NIDEK AFC-230 fundus camera · DR severity per modified Davis staging
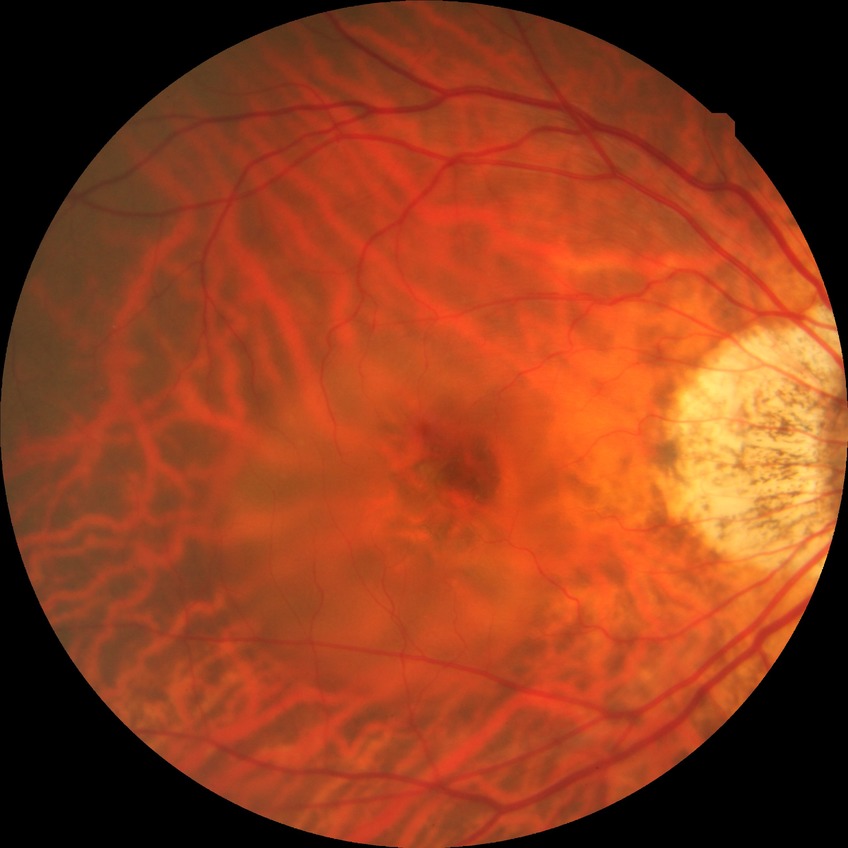

Retinopathy grade: no diabetic retinopathy.